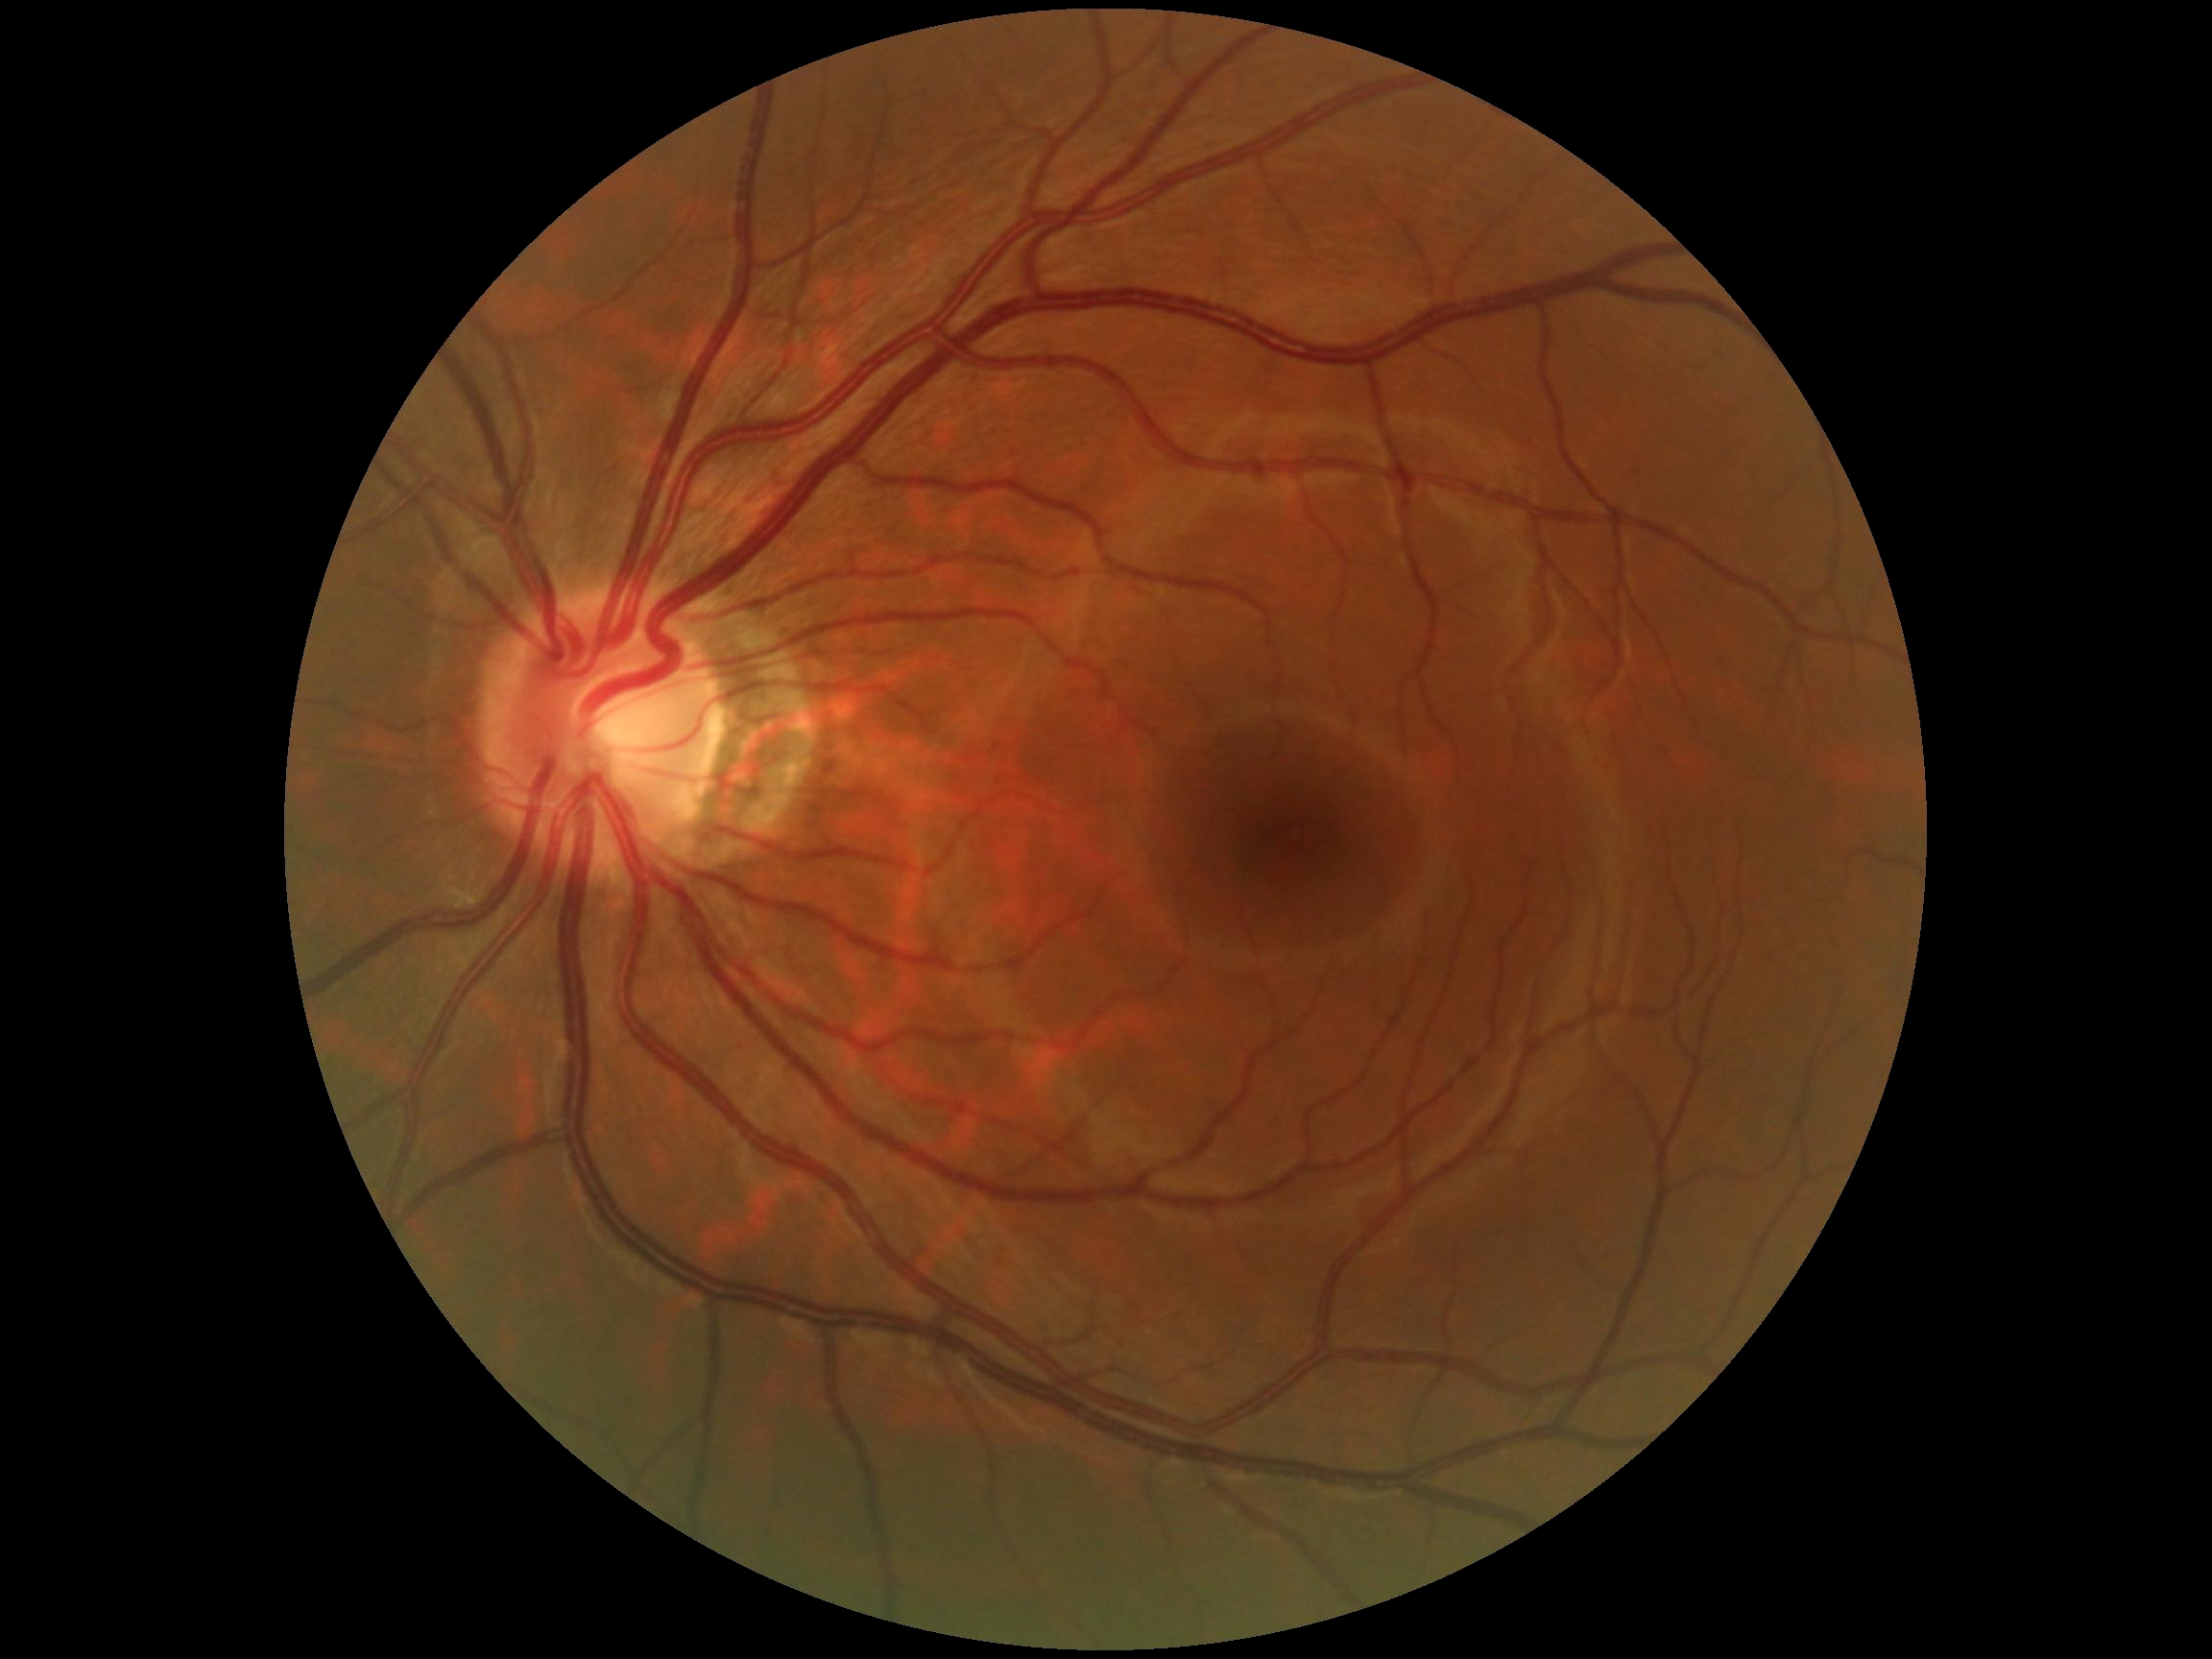 Diabetic retinopathy (DR): no apparent diabetic retinopathy (grade 0).